Wide-field fundus photograph from neonatal ROP screening. 1240x1240. Camera: Phoenix ICON (100° FOV) — 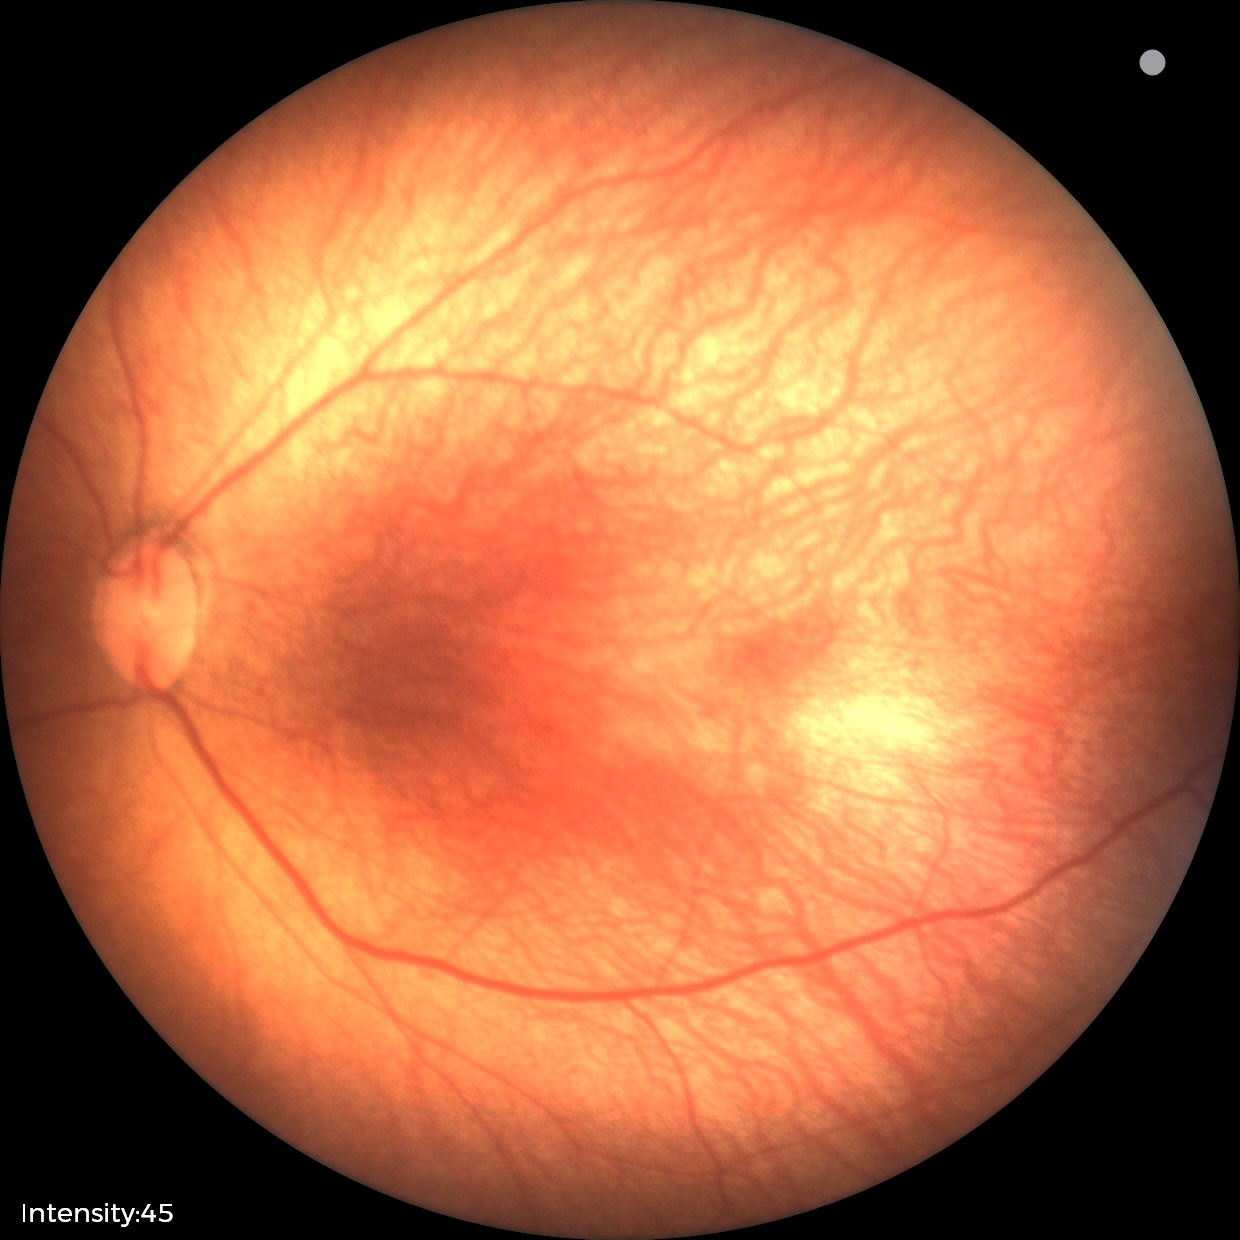 Examination diagnosed as retinopathy of prematurity (ROP) stage 1 — demarcation line between vascular and avascular retina.